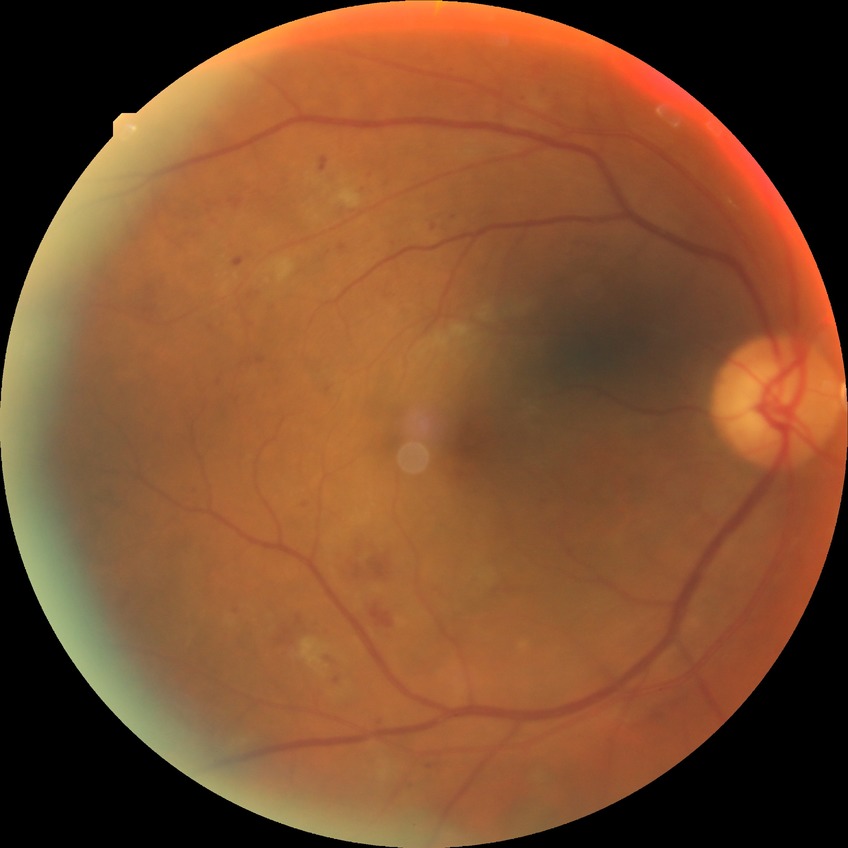
modified Davis grading: pre-proliferative diabetic retinopathy.